Captured on a Nidek AFC-330 fundus camera · captured without pupil dilation — 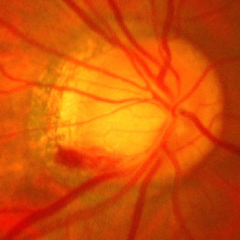

Diagnosis = advanced glaucoma.